2352 by 1568 pixels, 45° FOV: 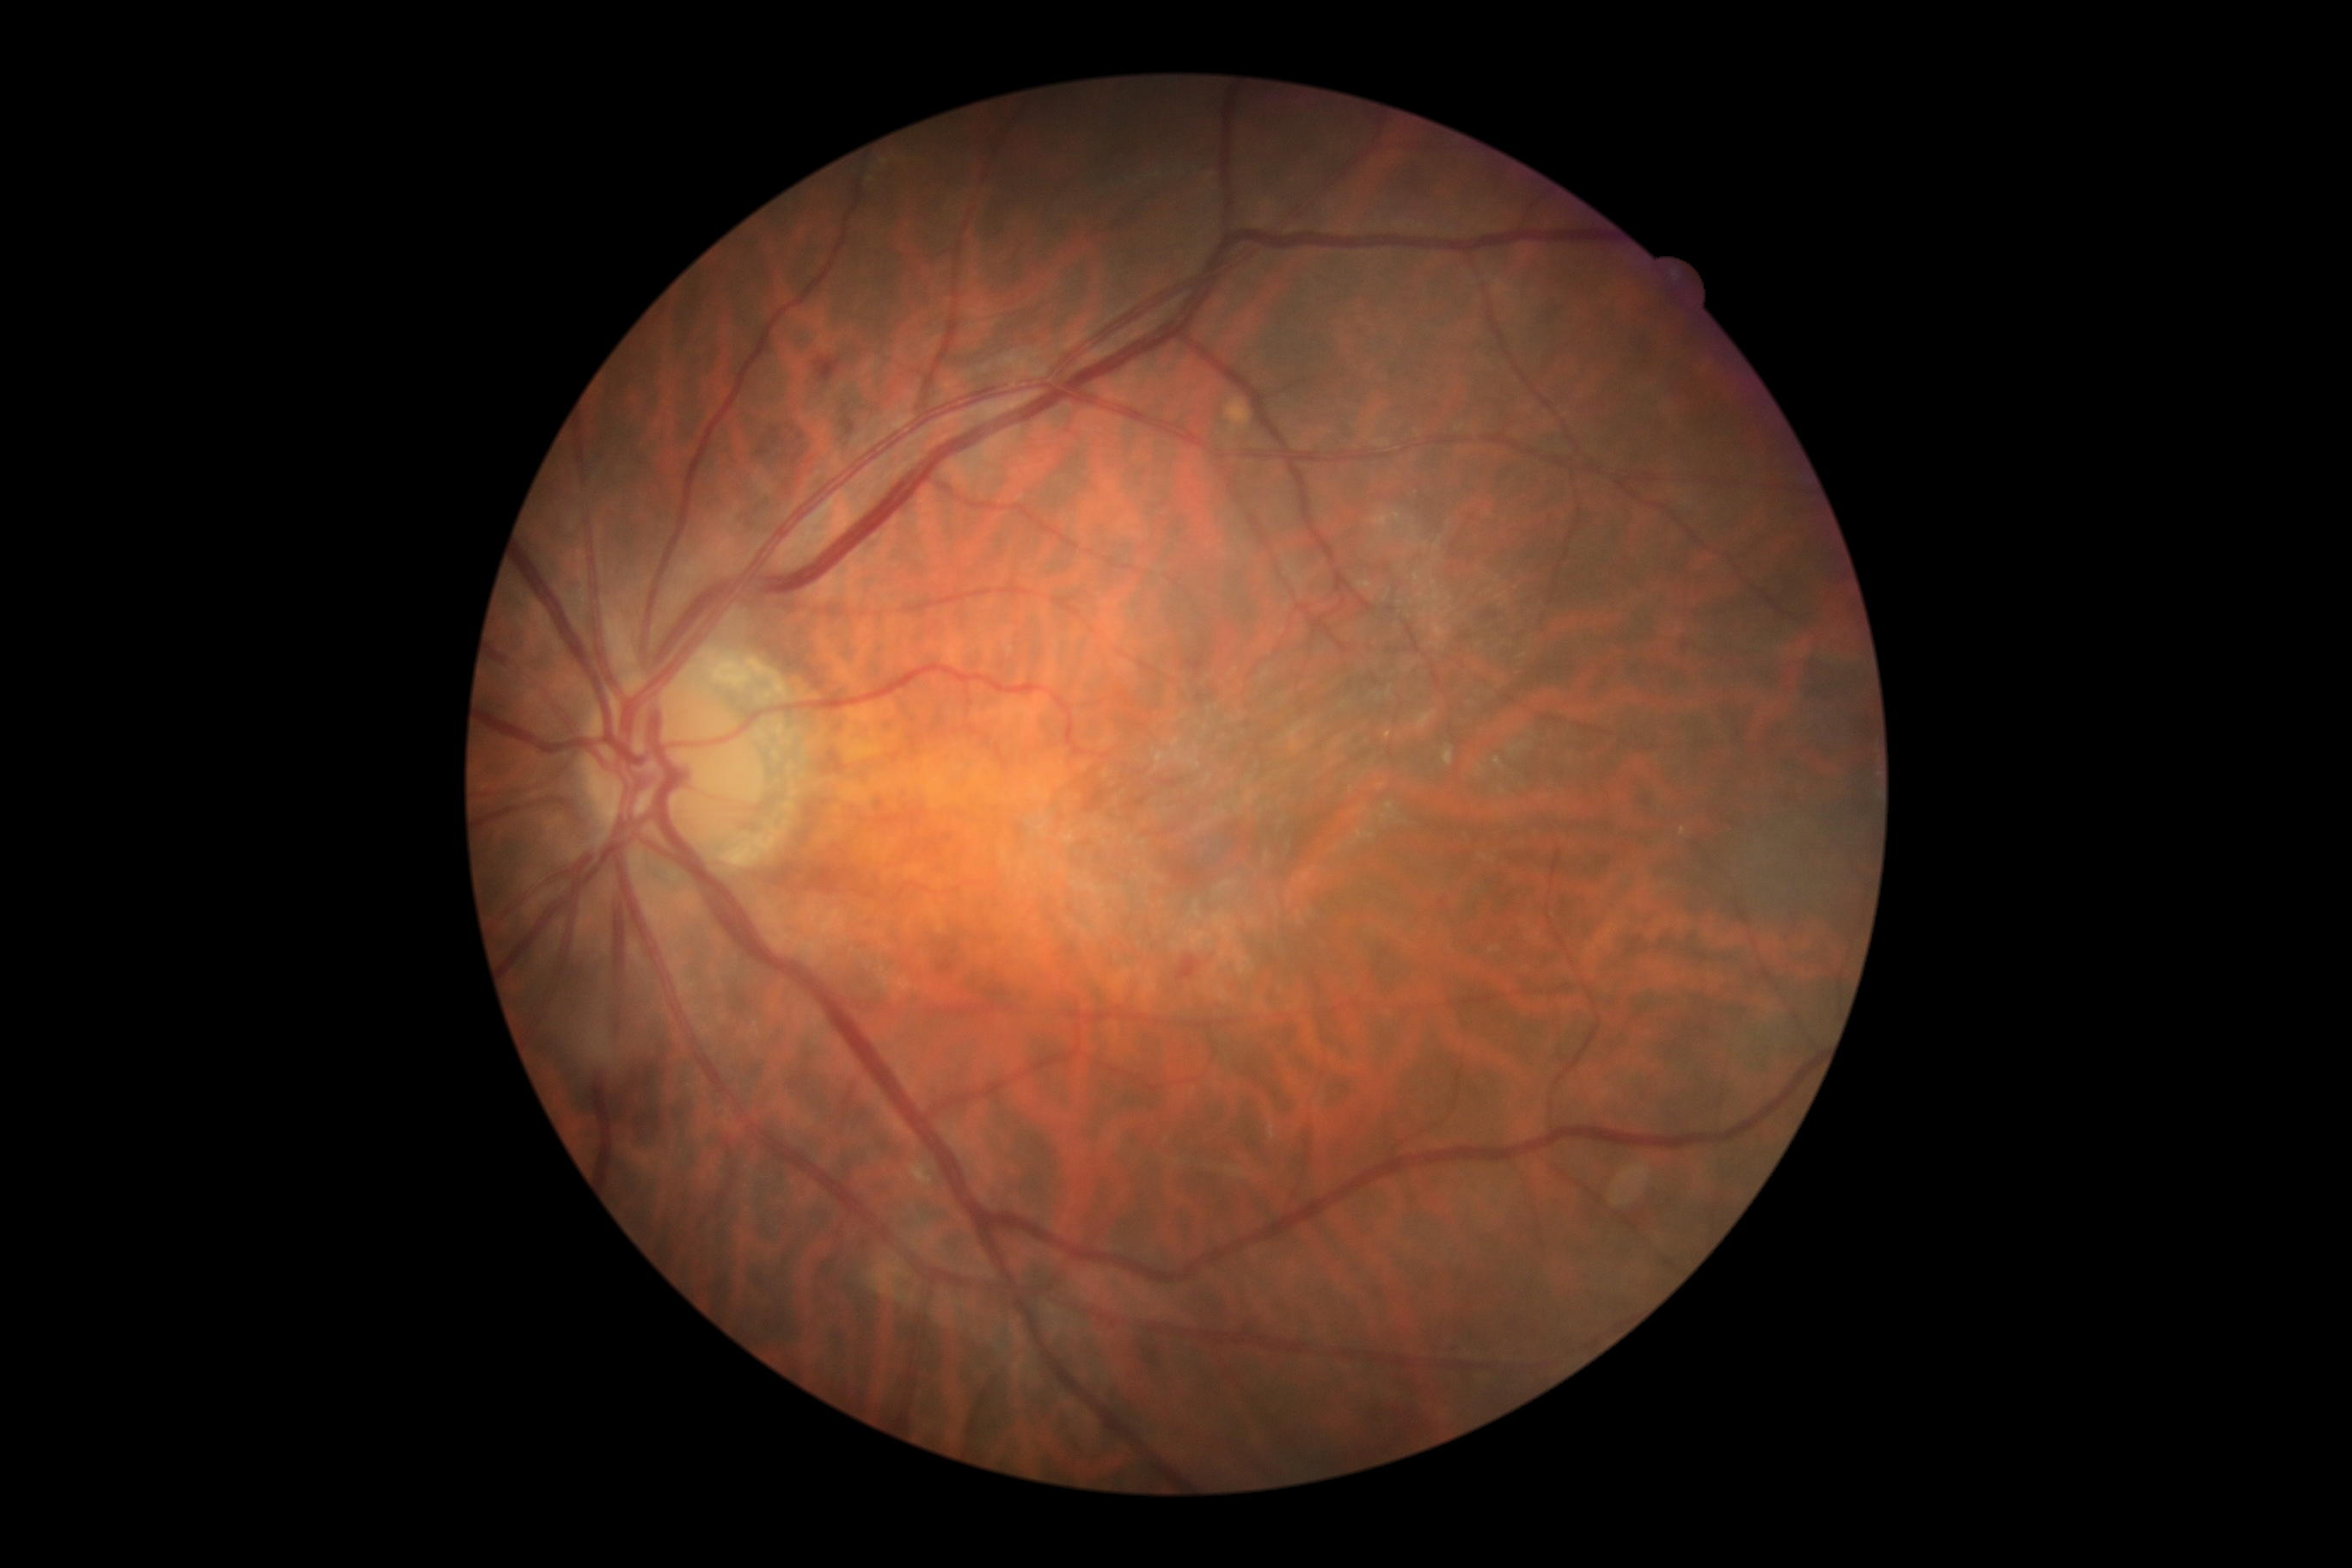 DR is grade 2. DR class: non-proliferative diabetic retinopathy.